50-degree field of view
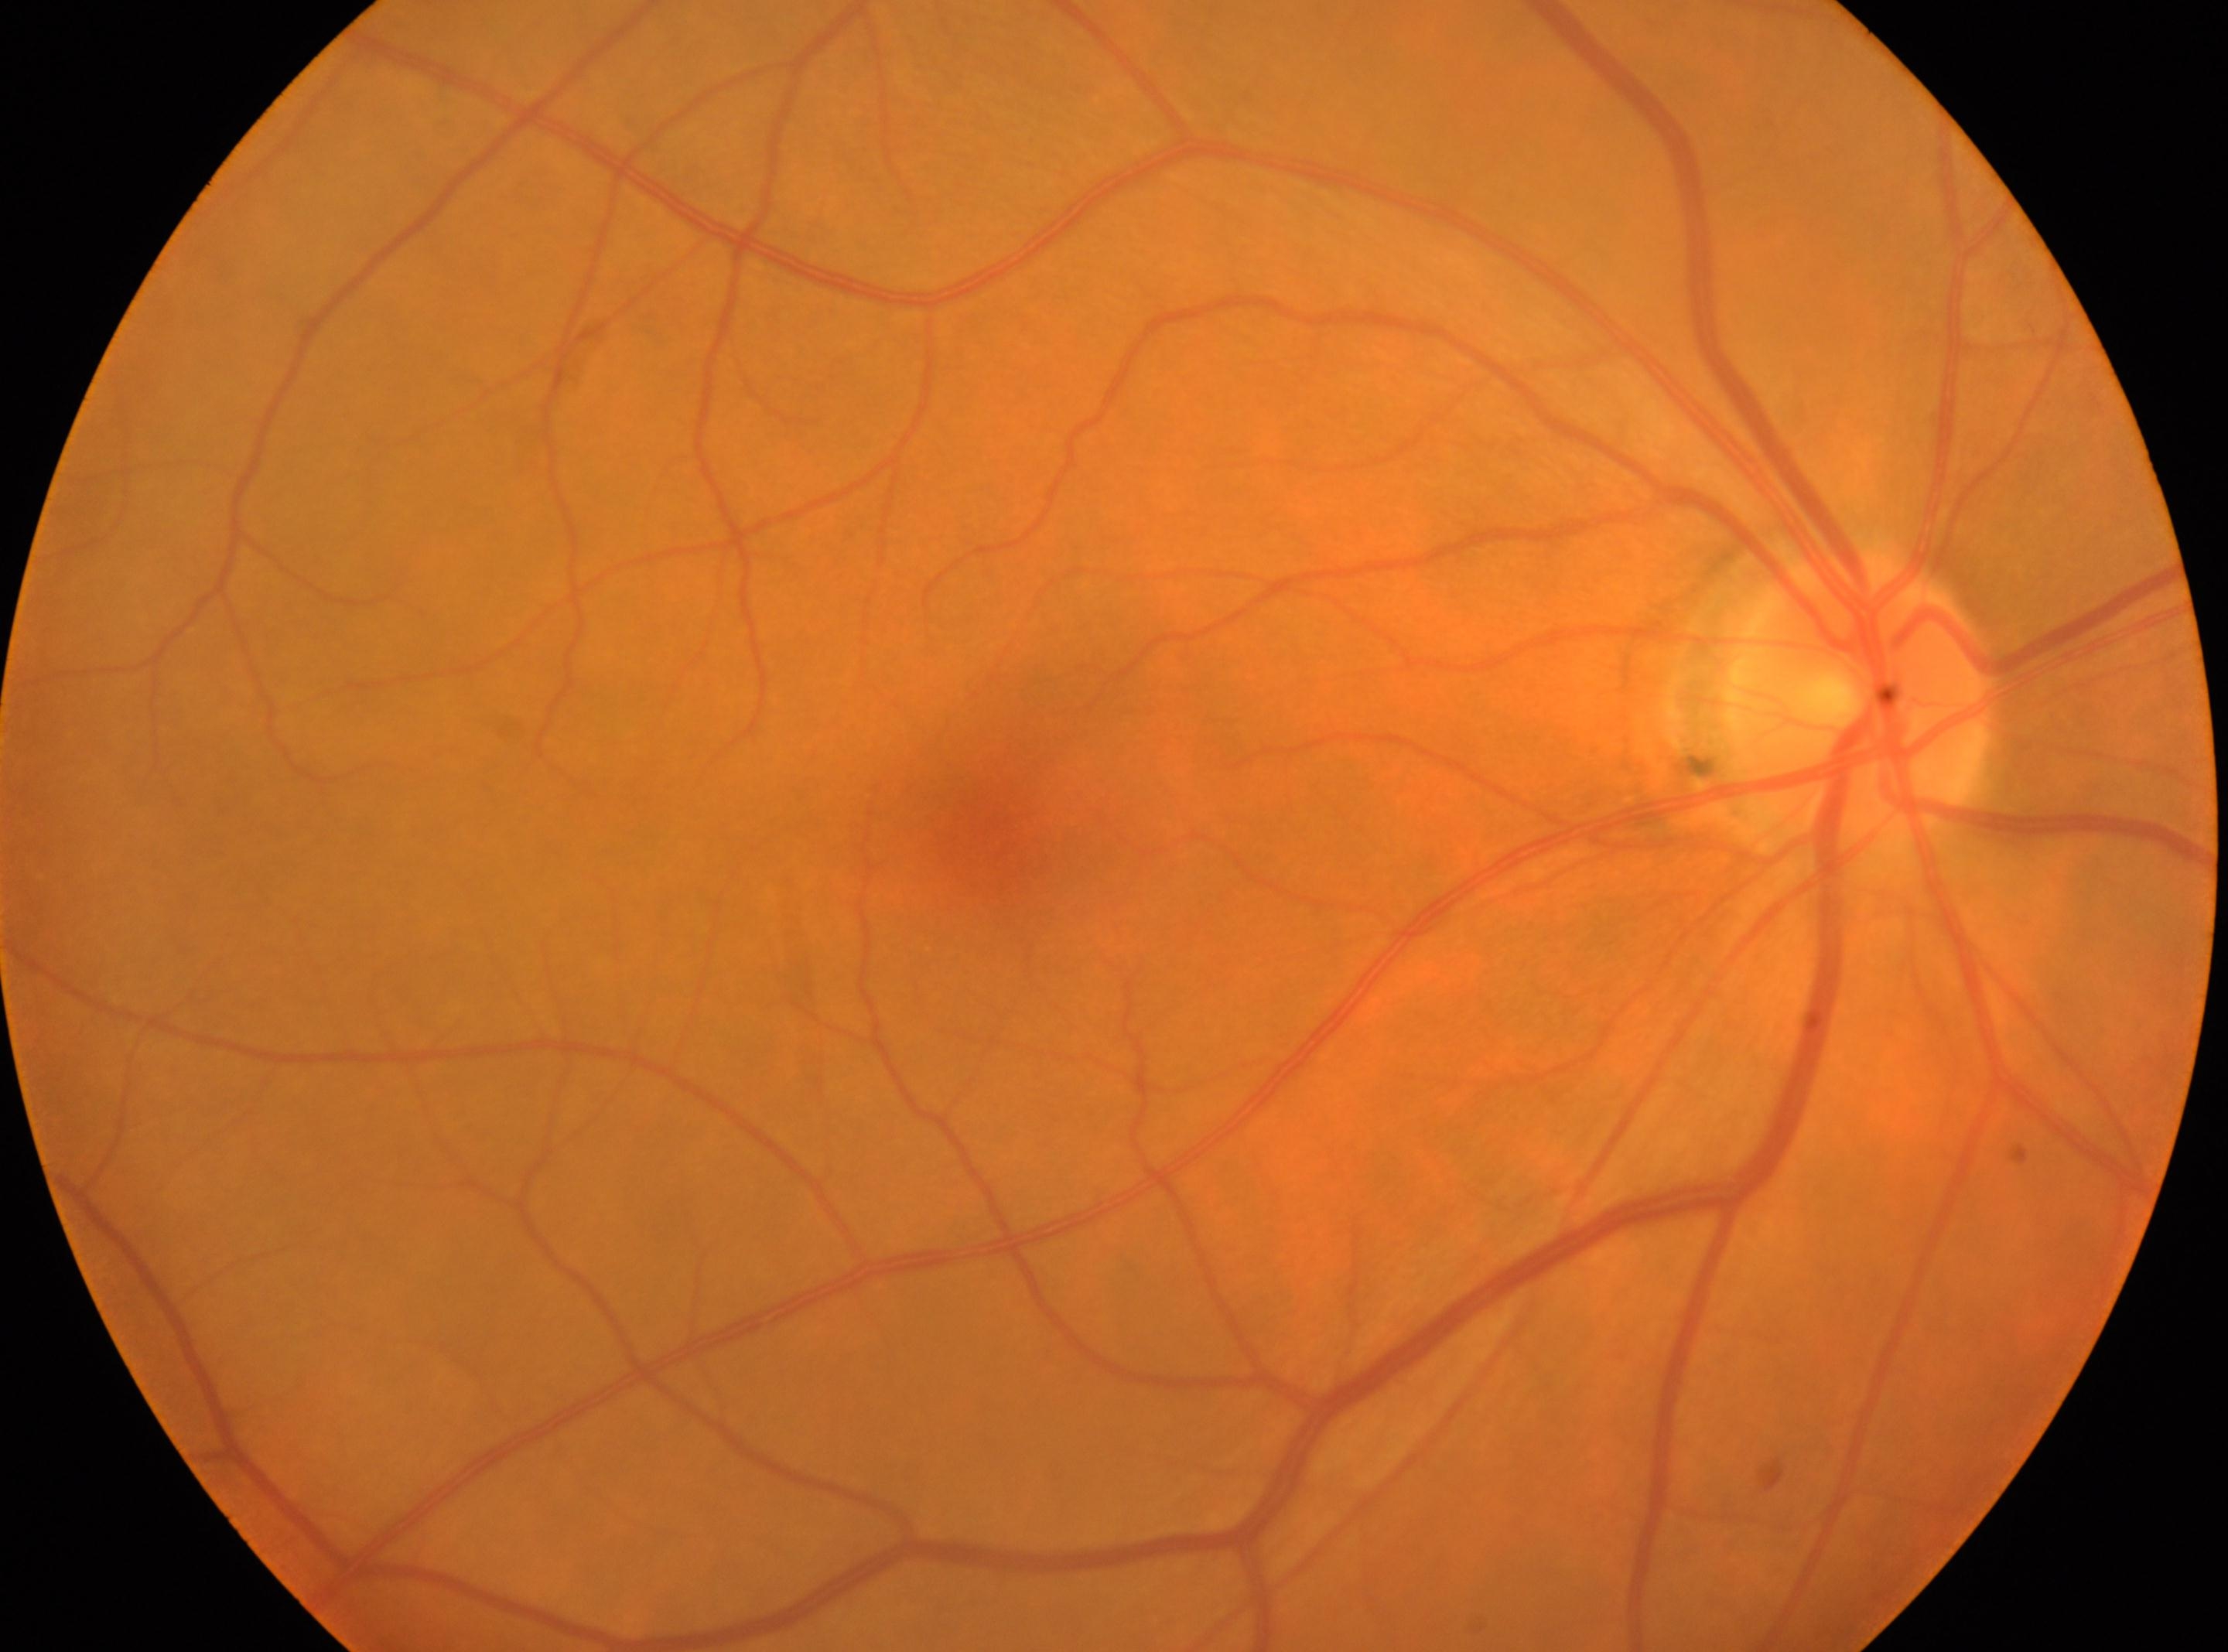 optic disk = (1860, 693) | macula center = (987, 834) | laterality = right | DR stage = no apparent diabetic retinopathy (grade 0) — no visible signs of diabetic retinopathy.